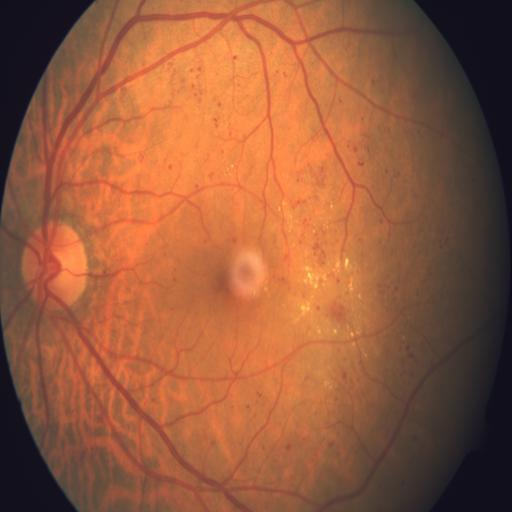 Diagnoses:
- exudation
- hemorrhagic retinopathy